45° FOV. 1932 x 1932 pixels. Retinal fundus photograph.
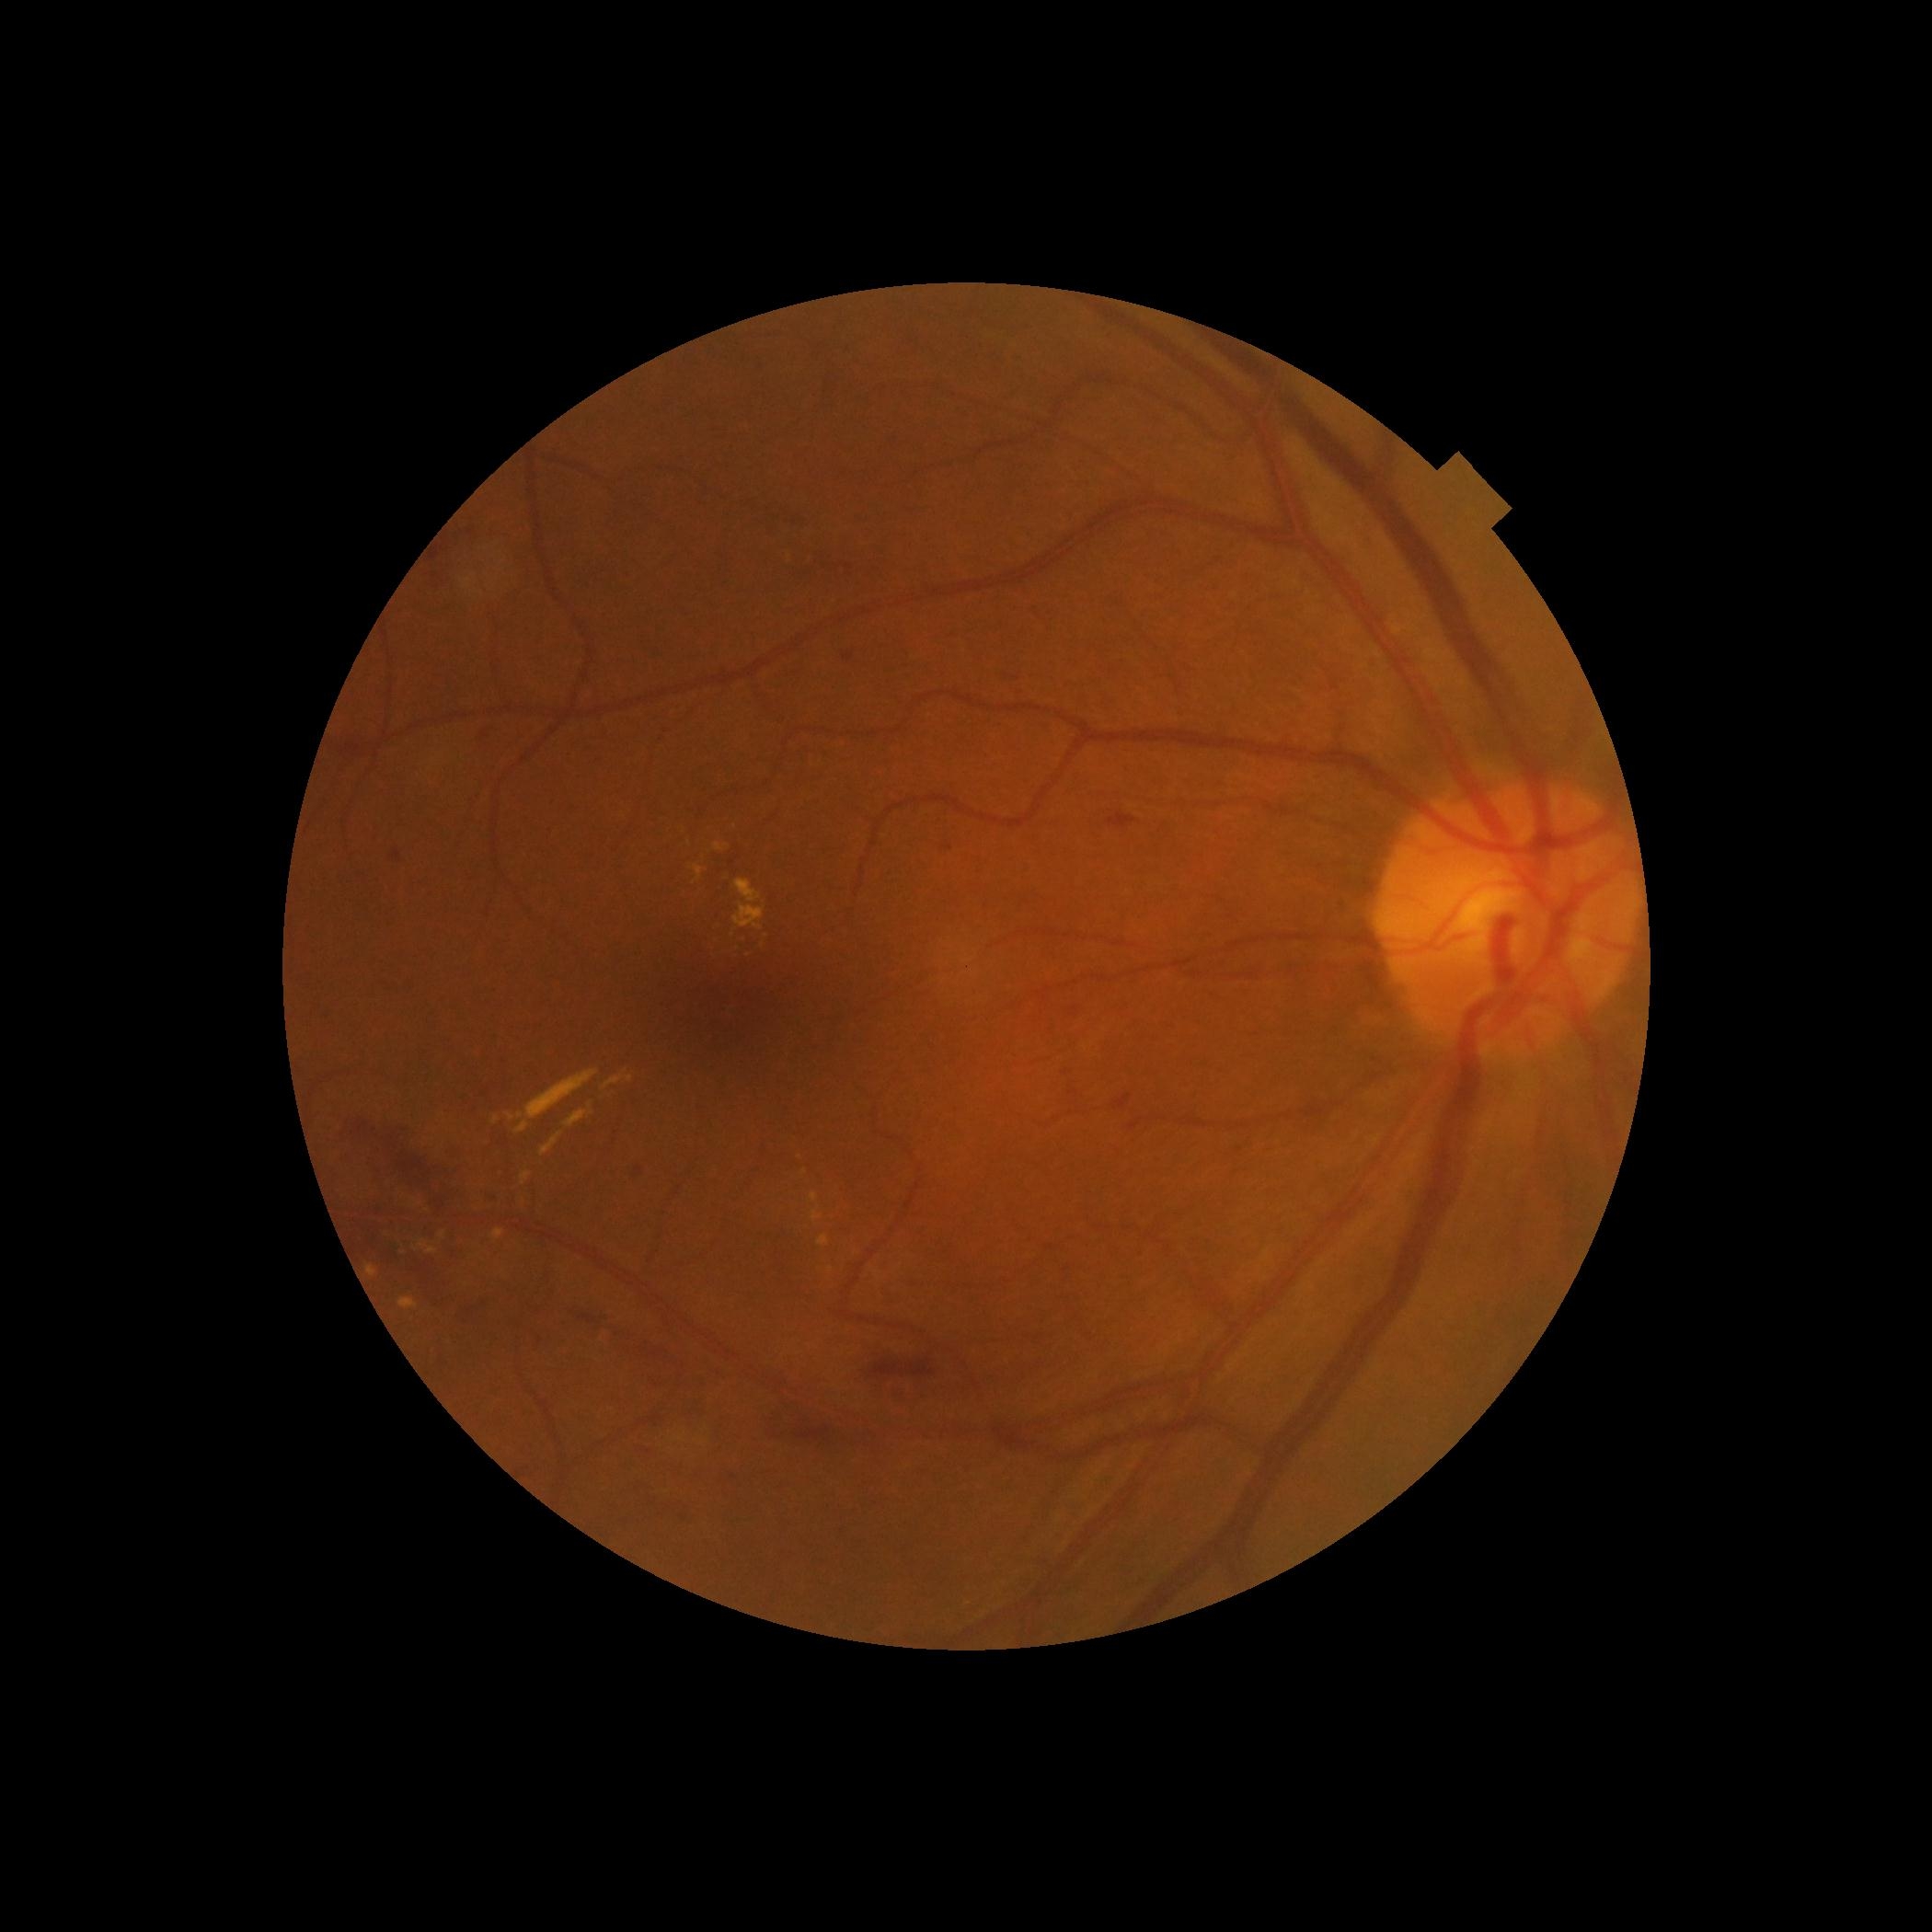
DR severity = 2/4.